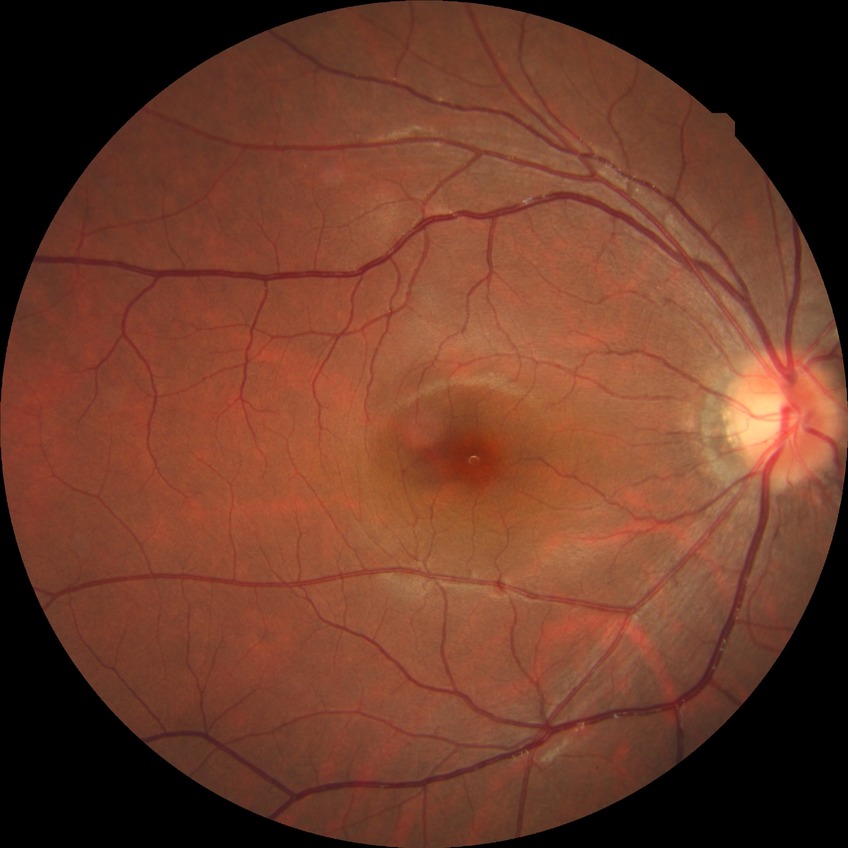

{"davis_grade": "no diabetic retinopathy"}